NIDEK AFC-230, graded on the modified Davis scale: 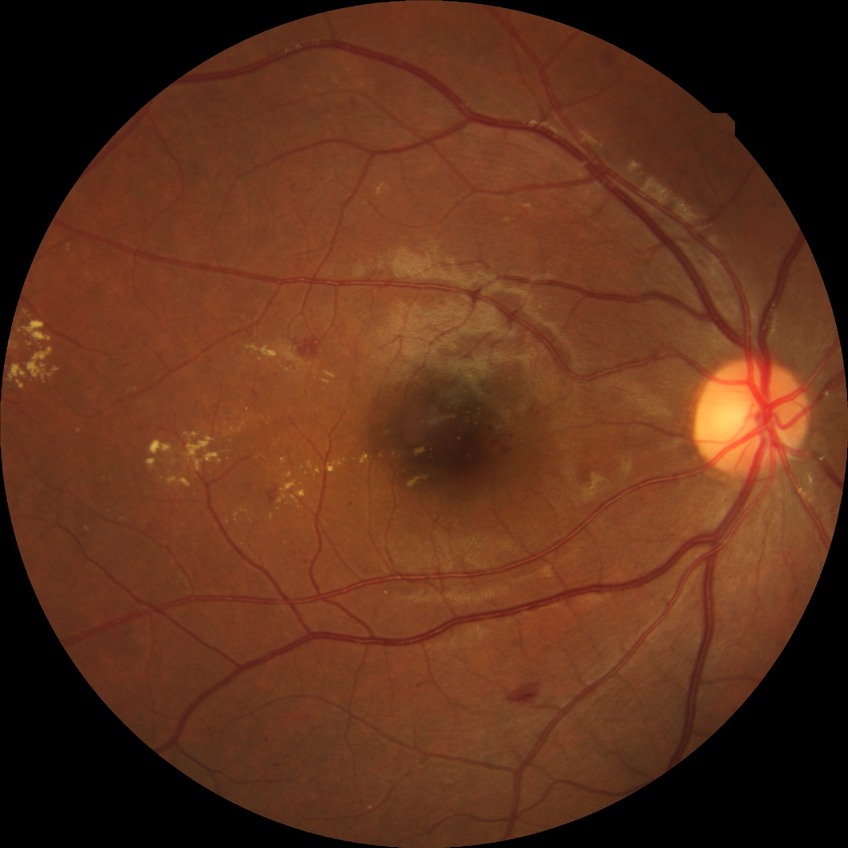 Disease class: non-proliferative diabetic retinopathy. Diabetic retinopathy (DR) is SDR (simple diabetic retinopathy).